45° field of view: 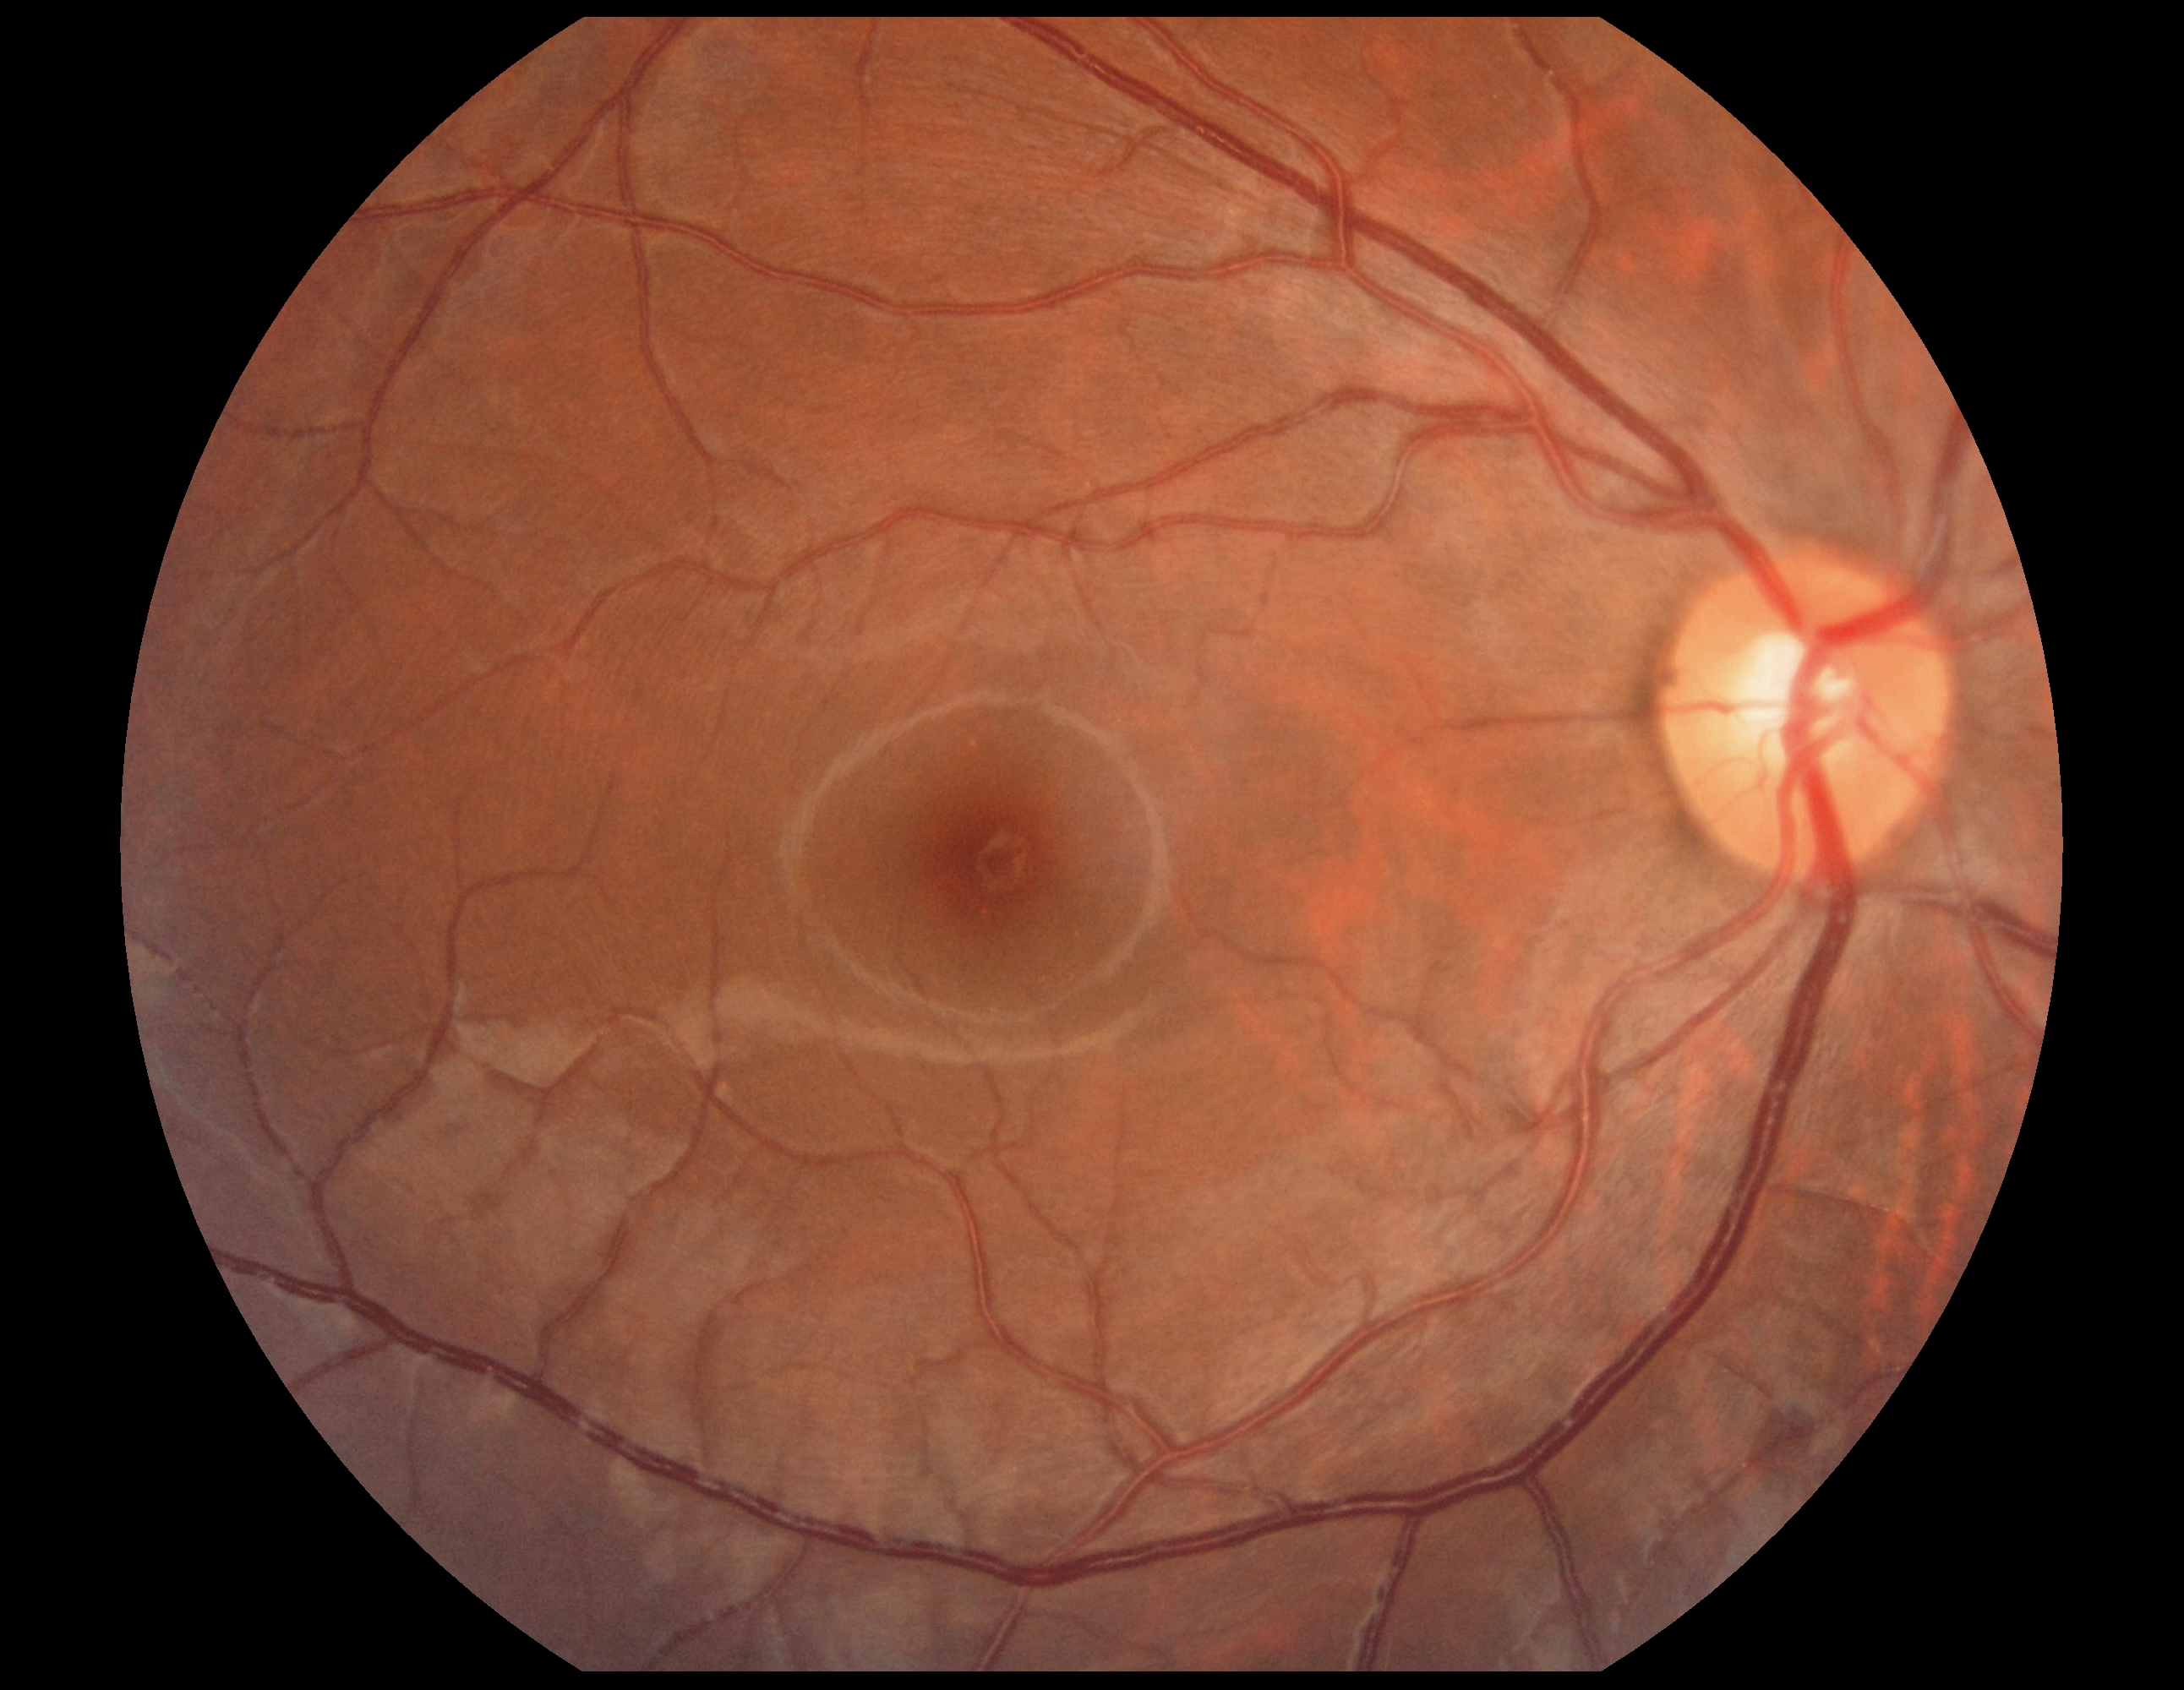 diabetic retinopathy (DR) = 0